848 x 848 pixels; NIDEK AFC-230
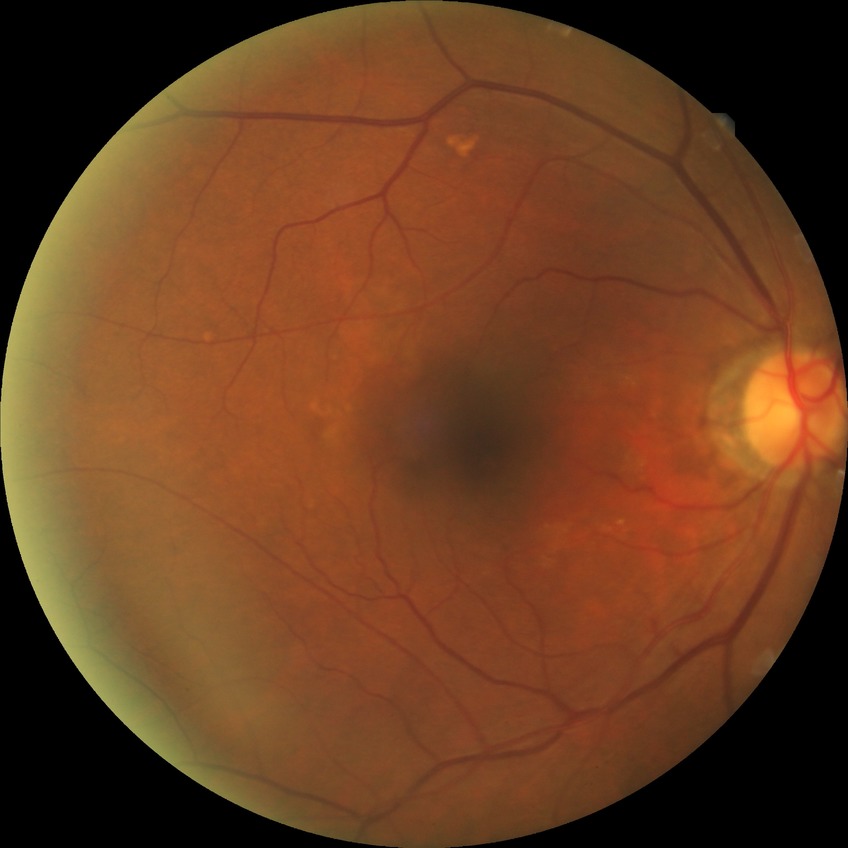

Diabetic retinopathy (DR) is NDR (no diabetic retinopathy).